Diabetic retinopathy graded by the modified Davis classification.
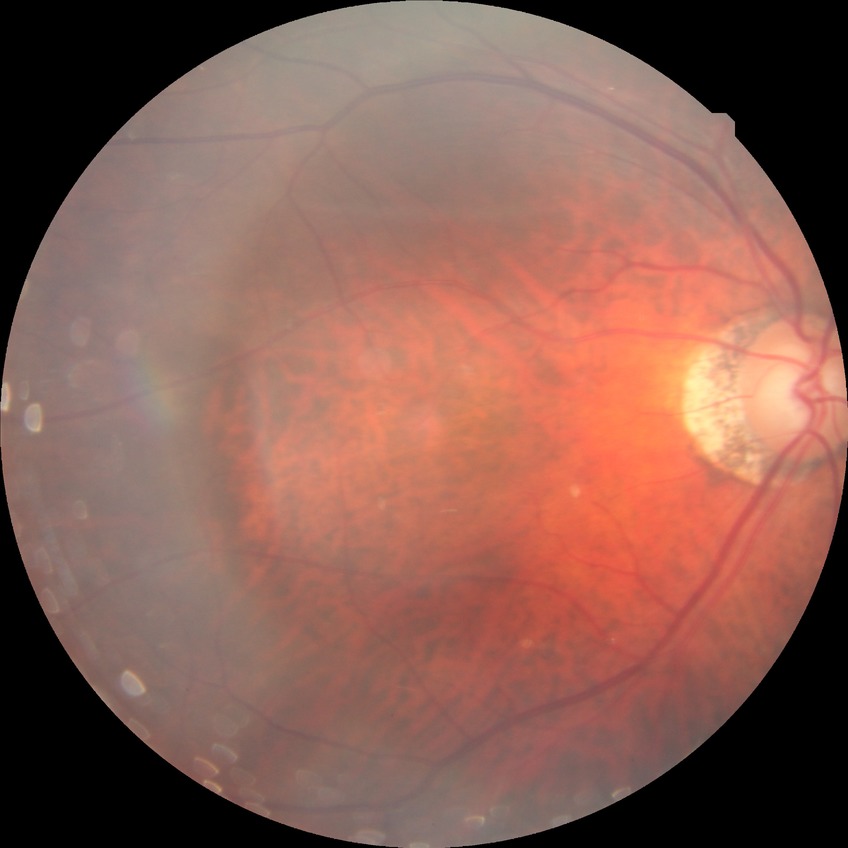

Diabetic retinopathy (DR) is no diabetic retinopathy (NDR).